45 degree fundus photograph.
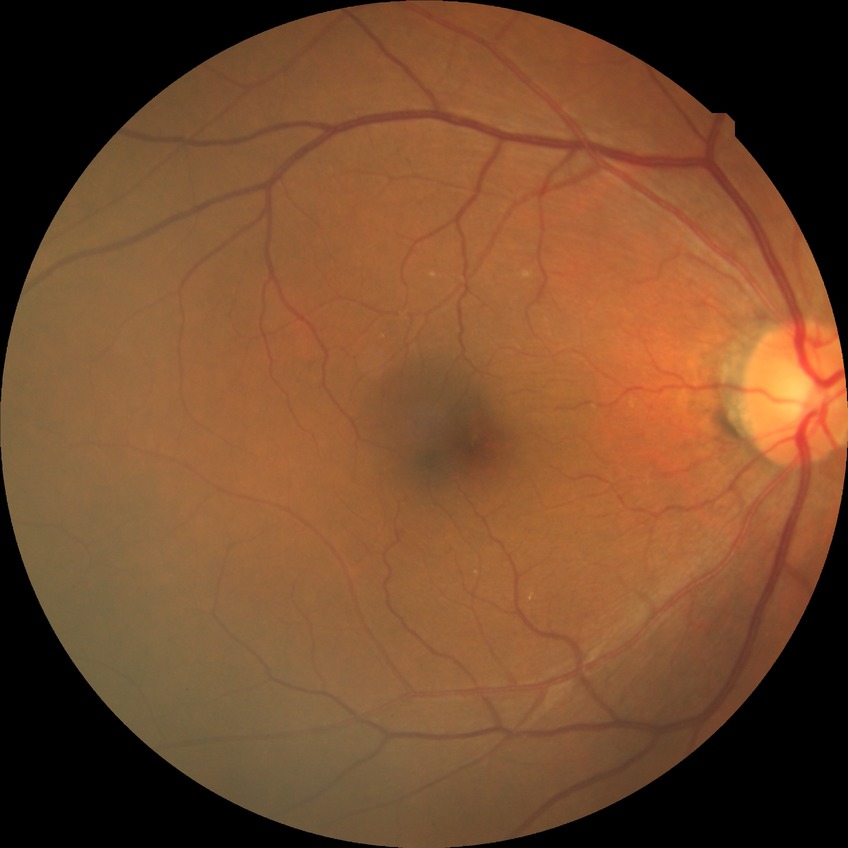
Assessment:
• modified Davis classification — no diabetic retinopathy